45° field of view
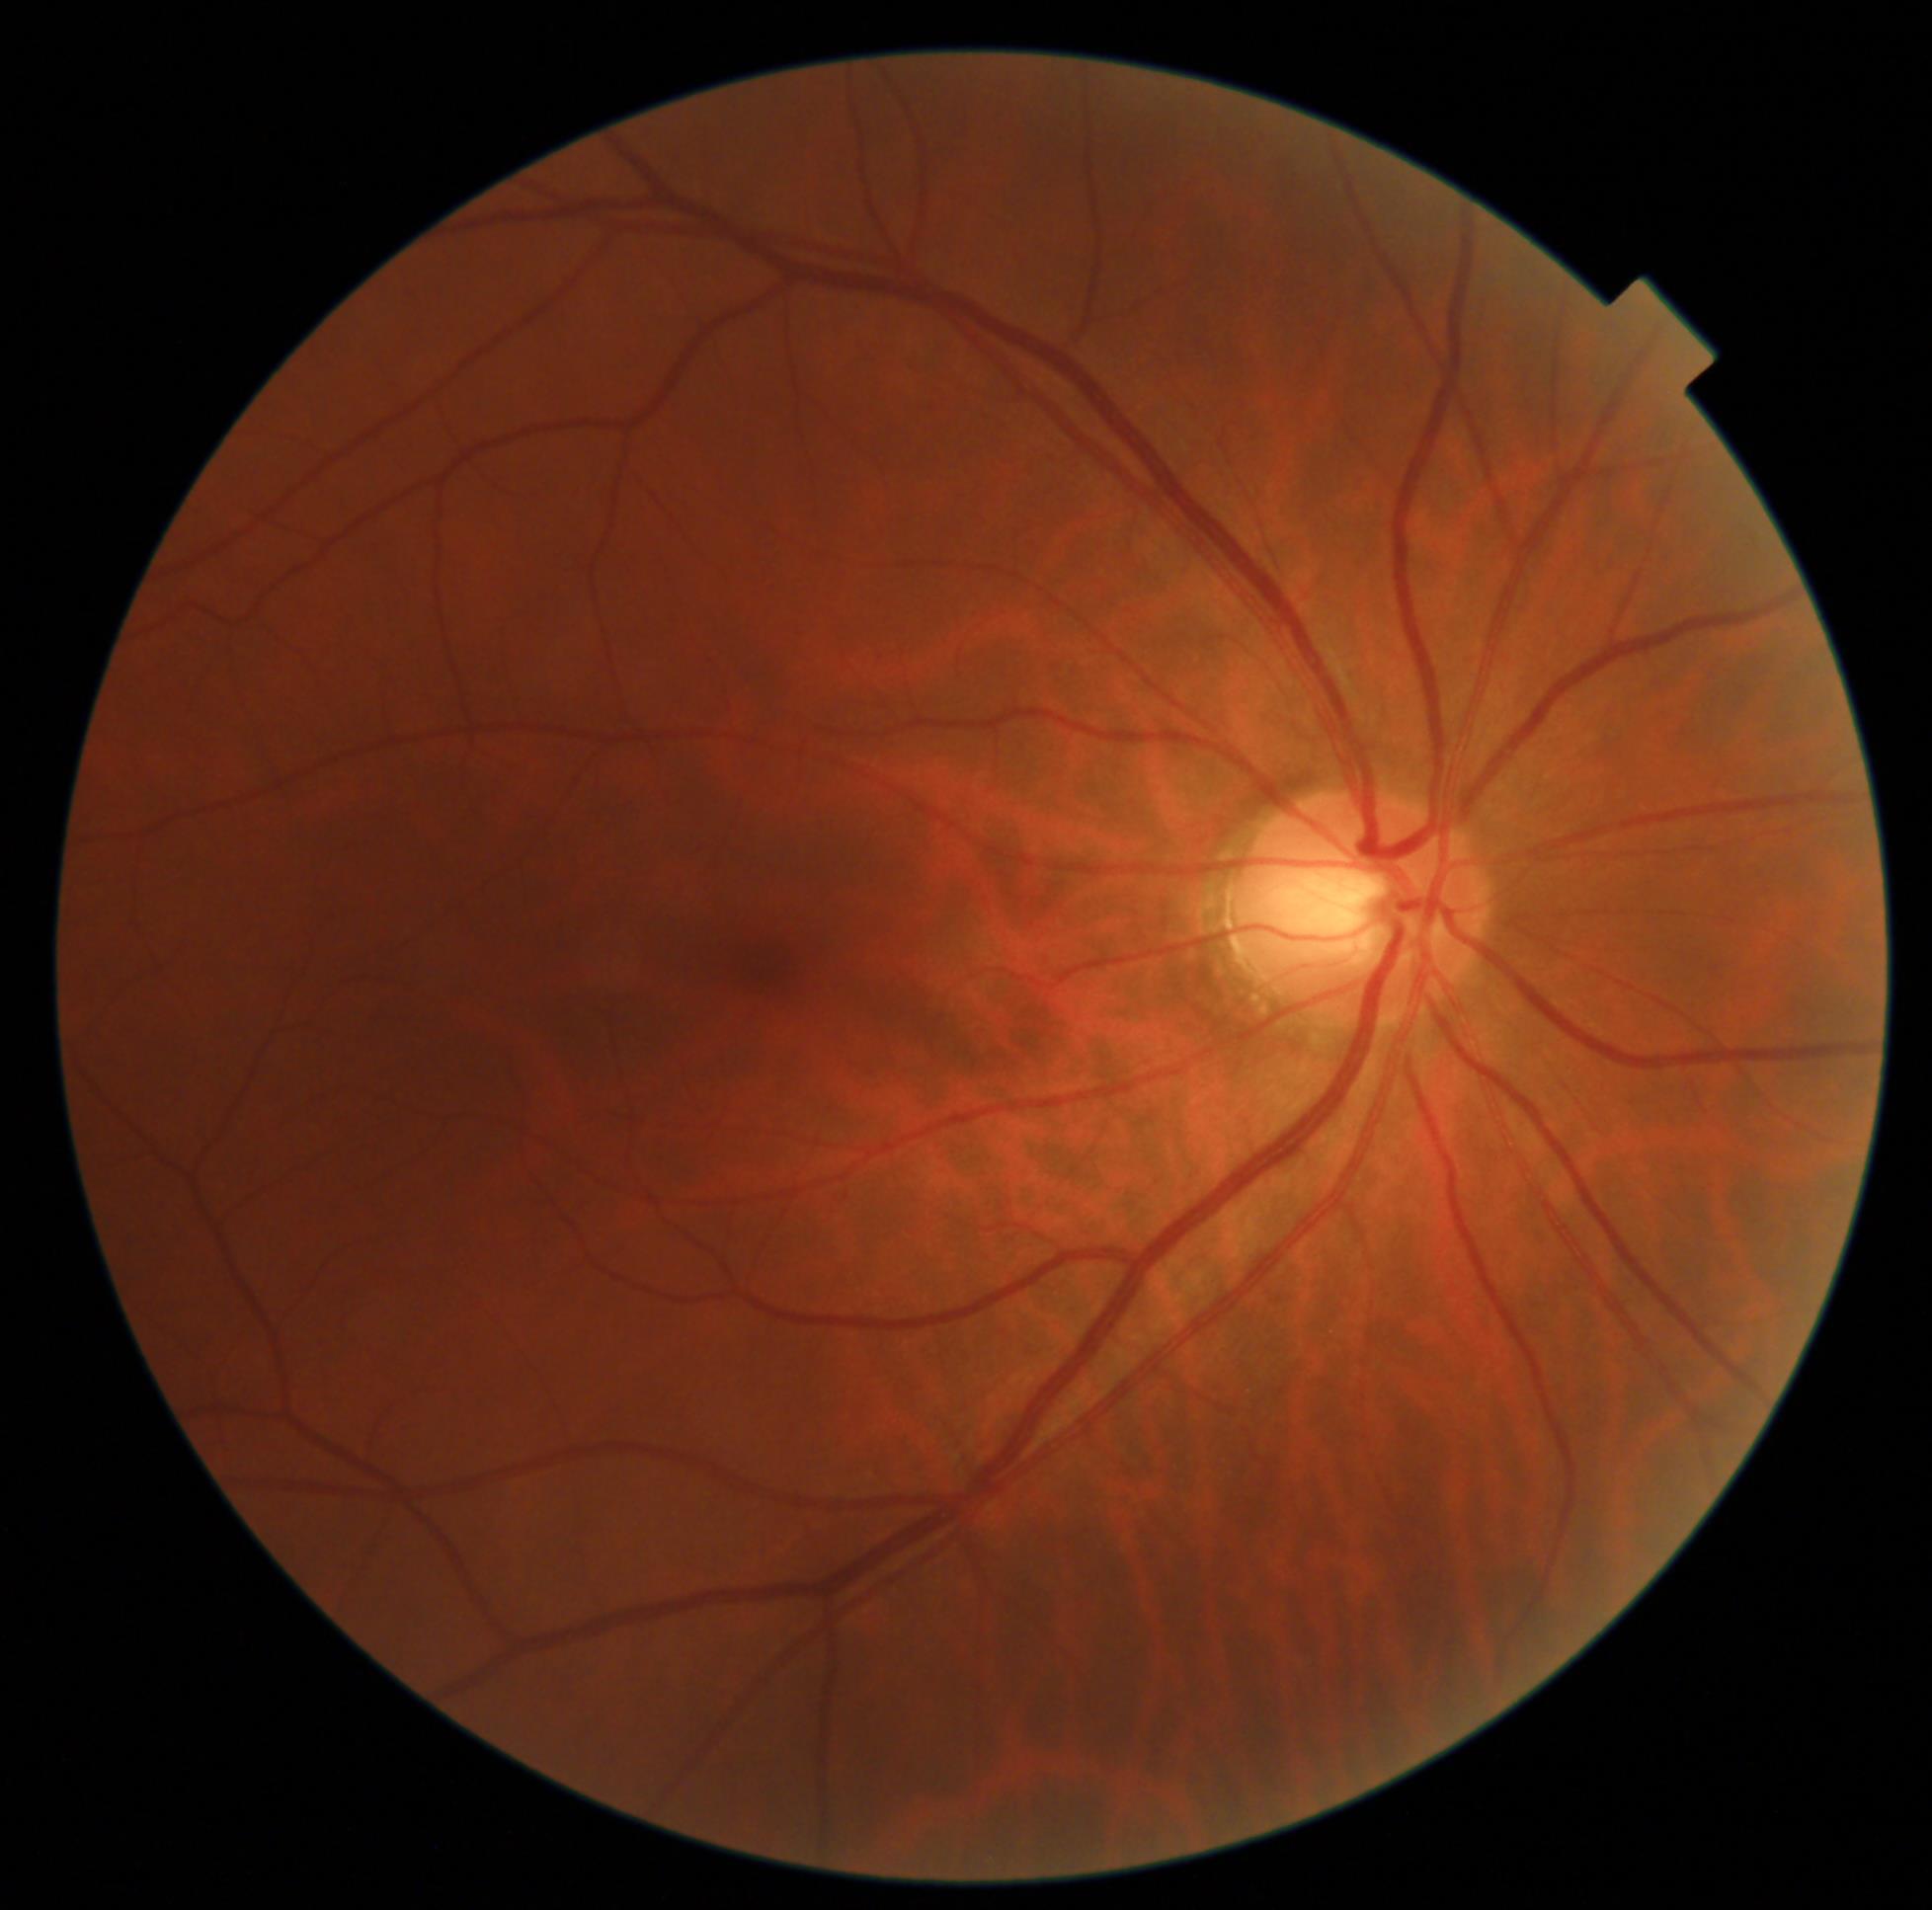 Diabetic retinopathy grade is no apparent retinopathy (0).